35° field of view before cropping · ONH-centered crop from a color fundus image:
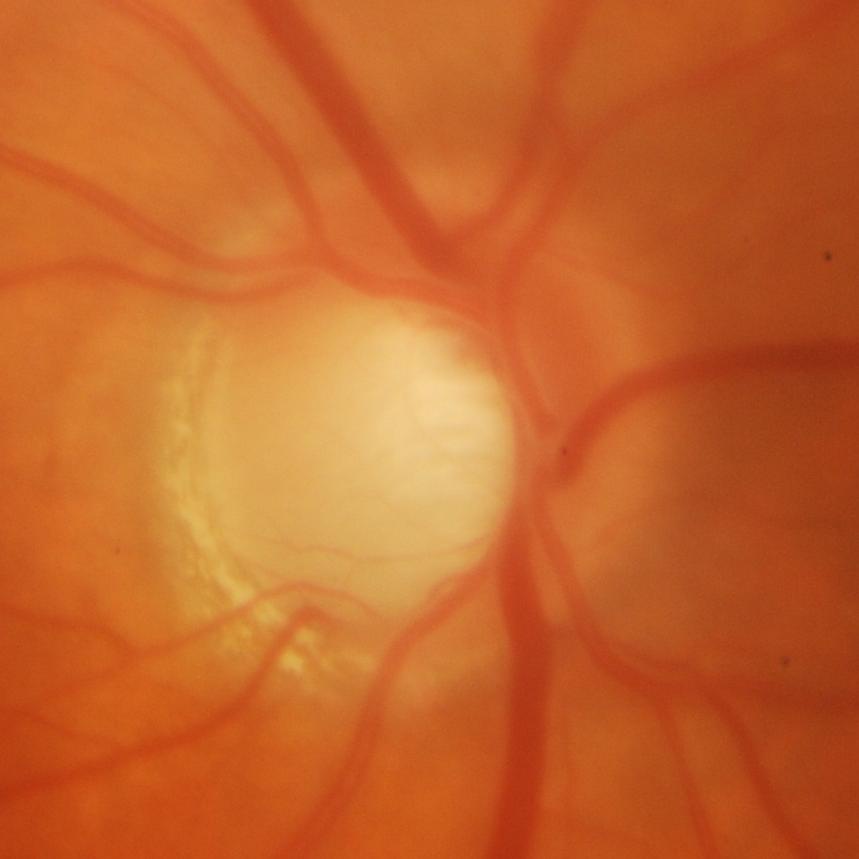
Glaucomatous optic neuropathy is present. Glaucoma assessment = glaucomatous findings.